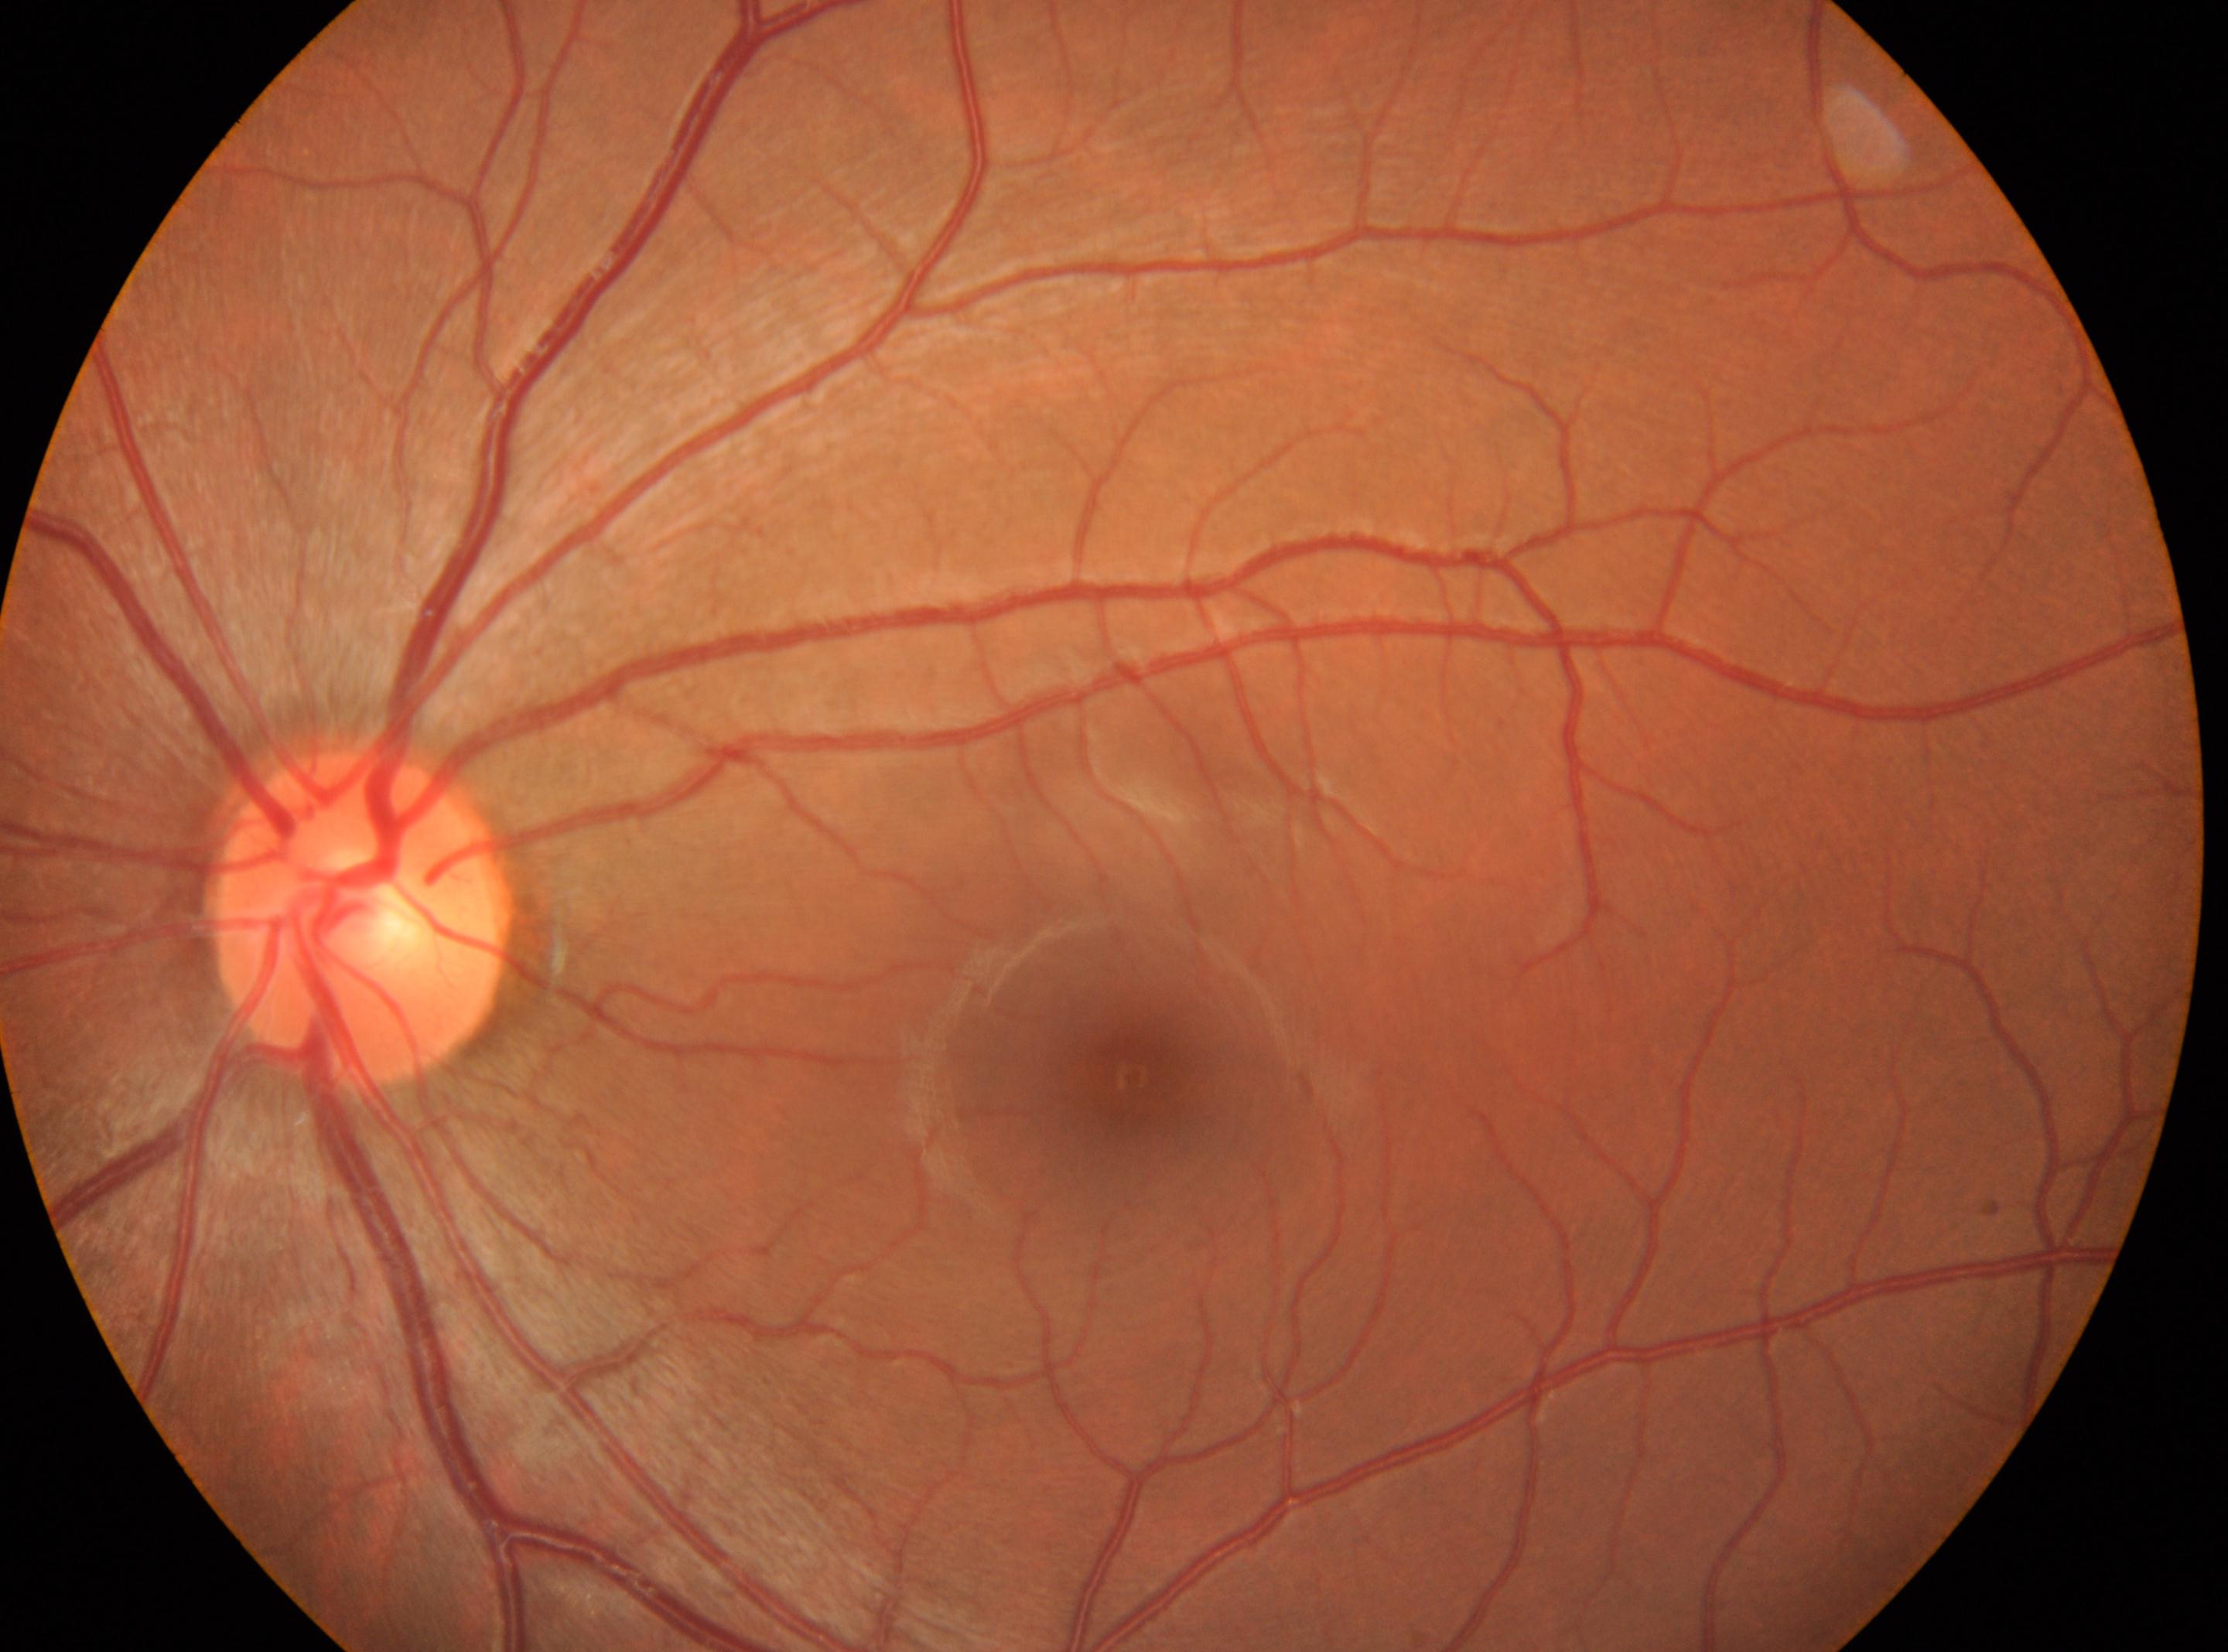
| key | value |
|---|---|
| DR grade | 0 |
| macula center | 1133px, 1075px |
| eye | OS |
| optic disc | 361px, 918px |